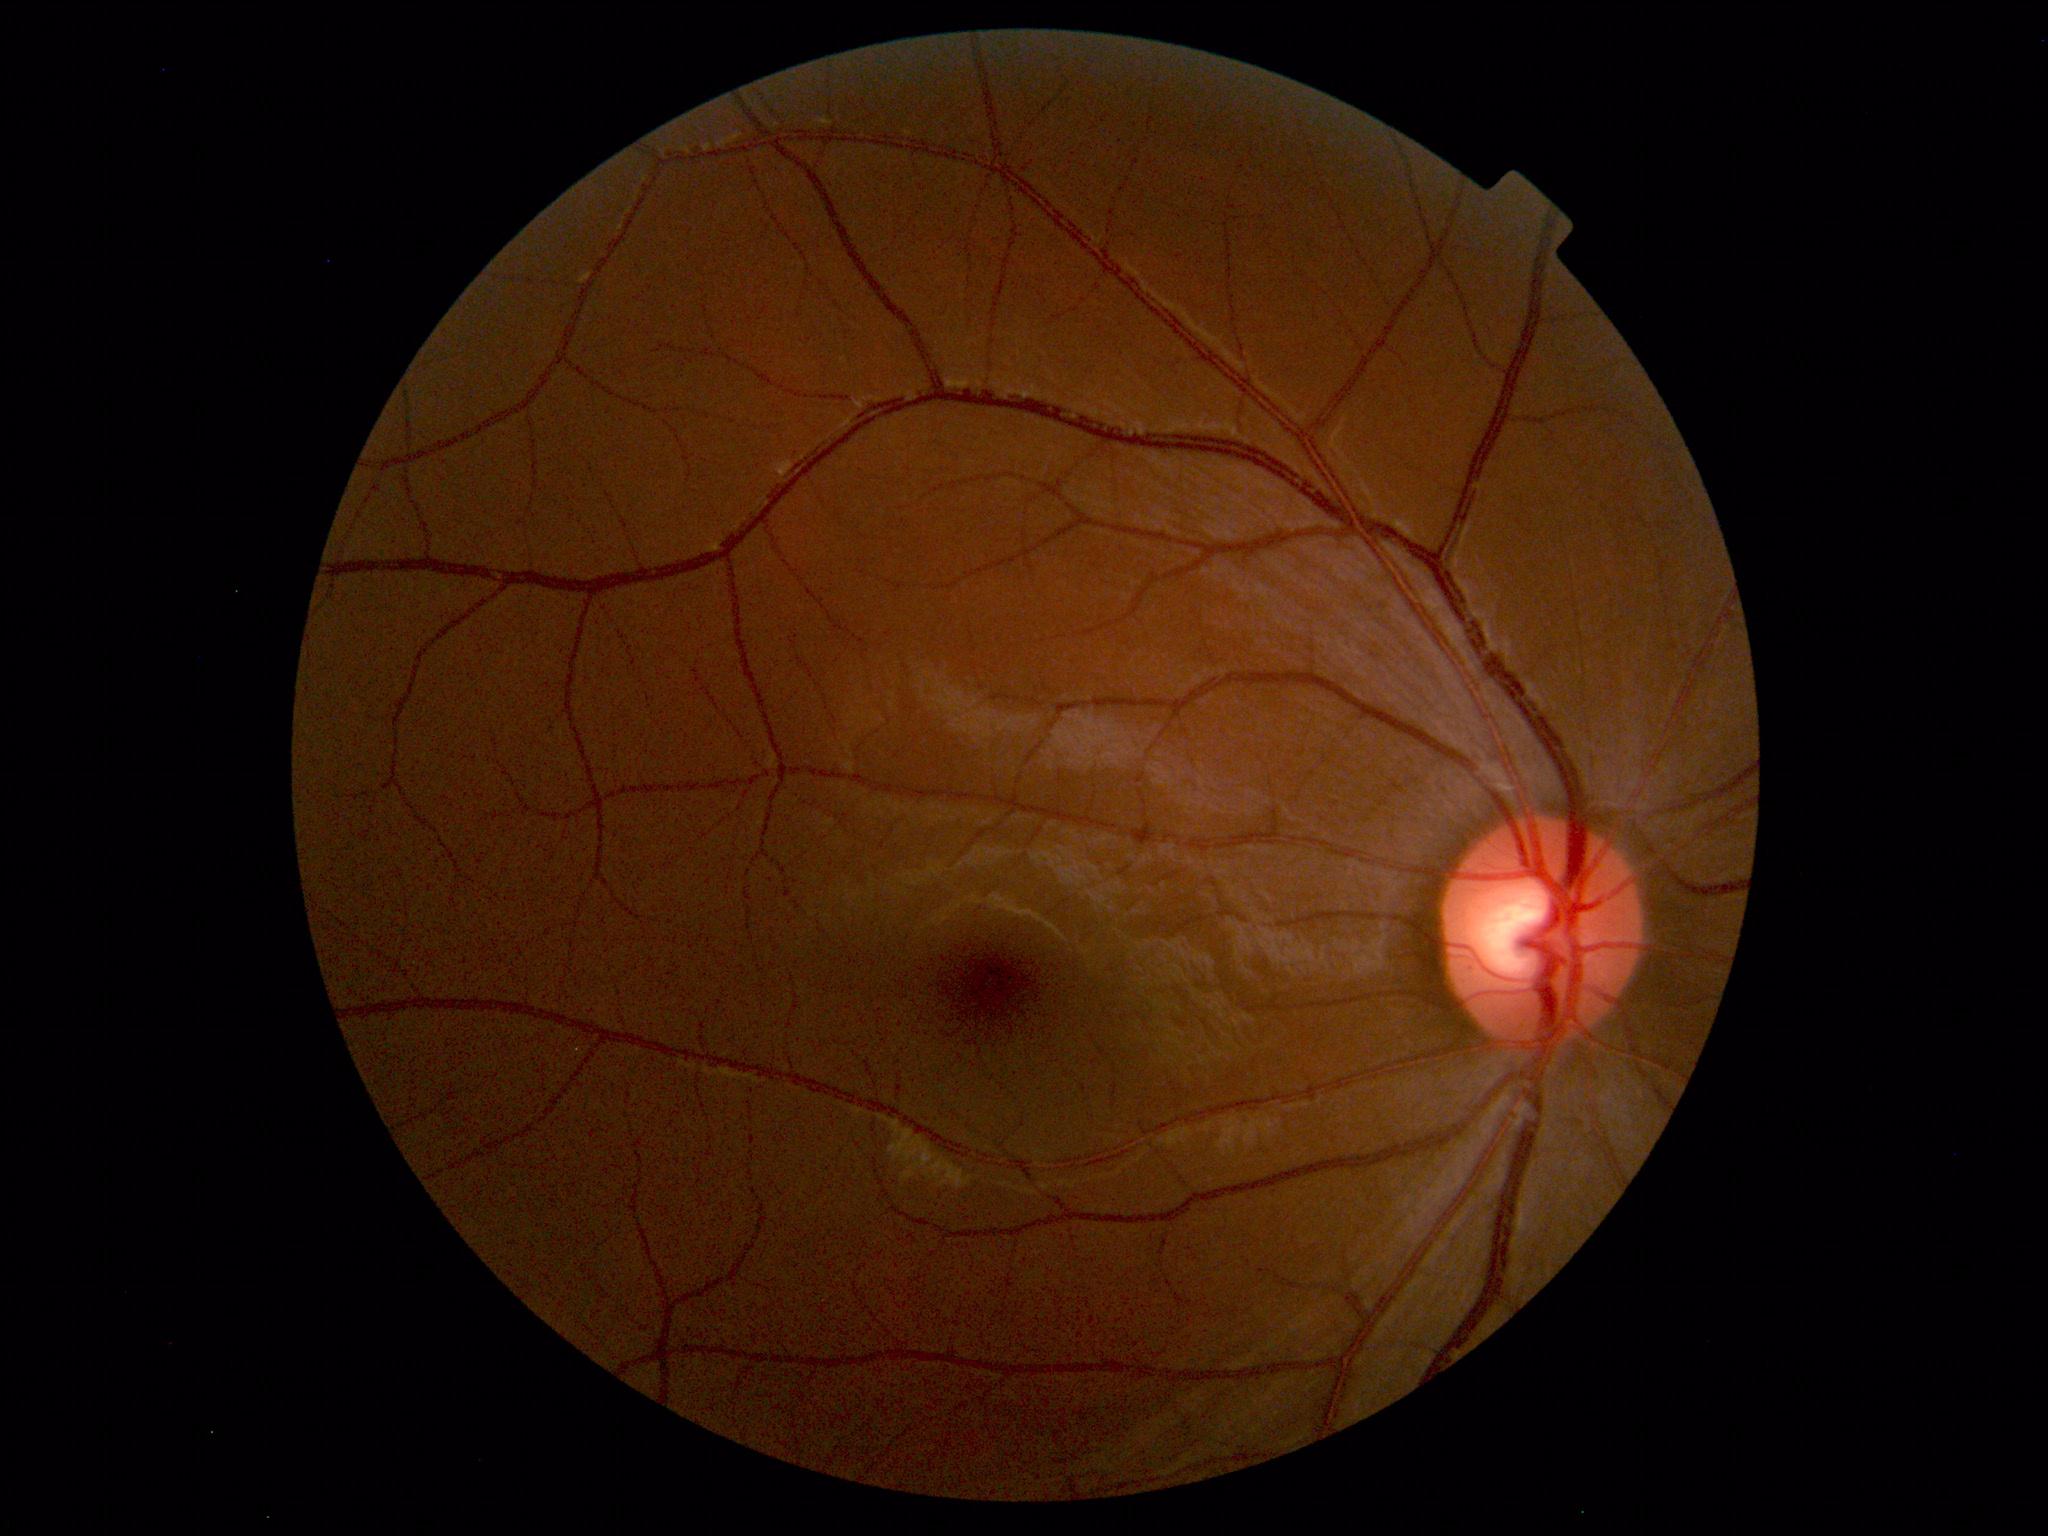 Impression: normal fundus.